Image size 848x848, FOV: 45 degrees, without pupil dilation, NIDEK AFC-230, posterior pole photograph — 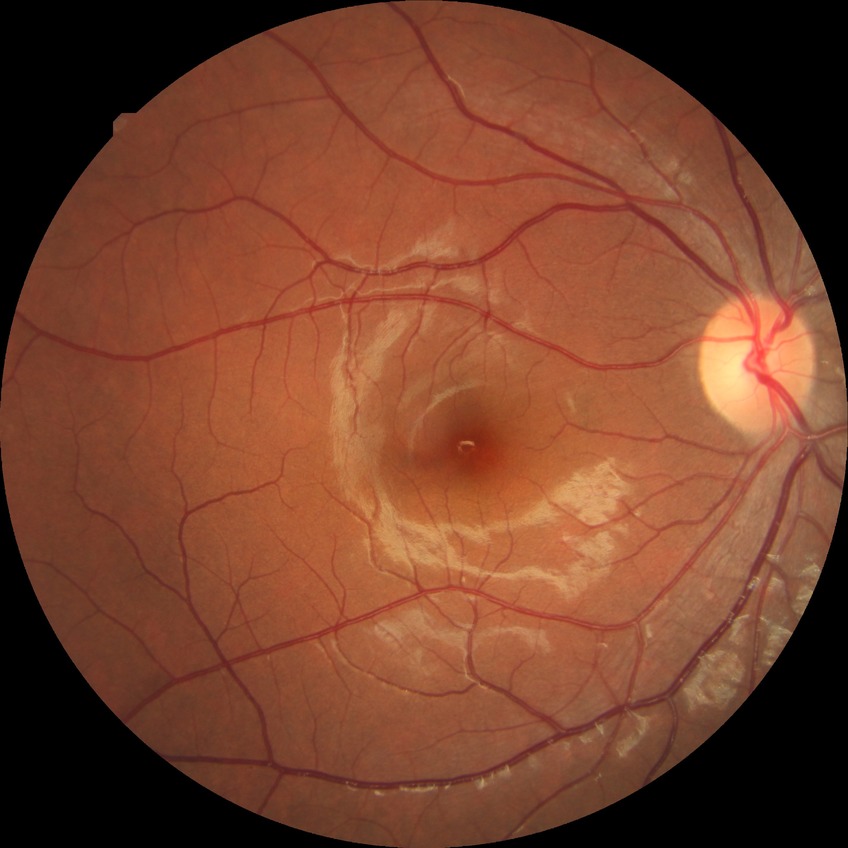

diabetic retinopathy severity@no diabetic retinopathy.